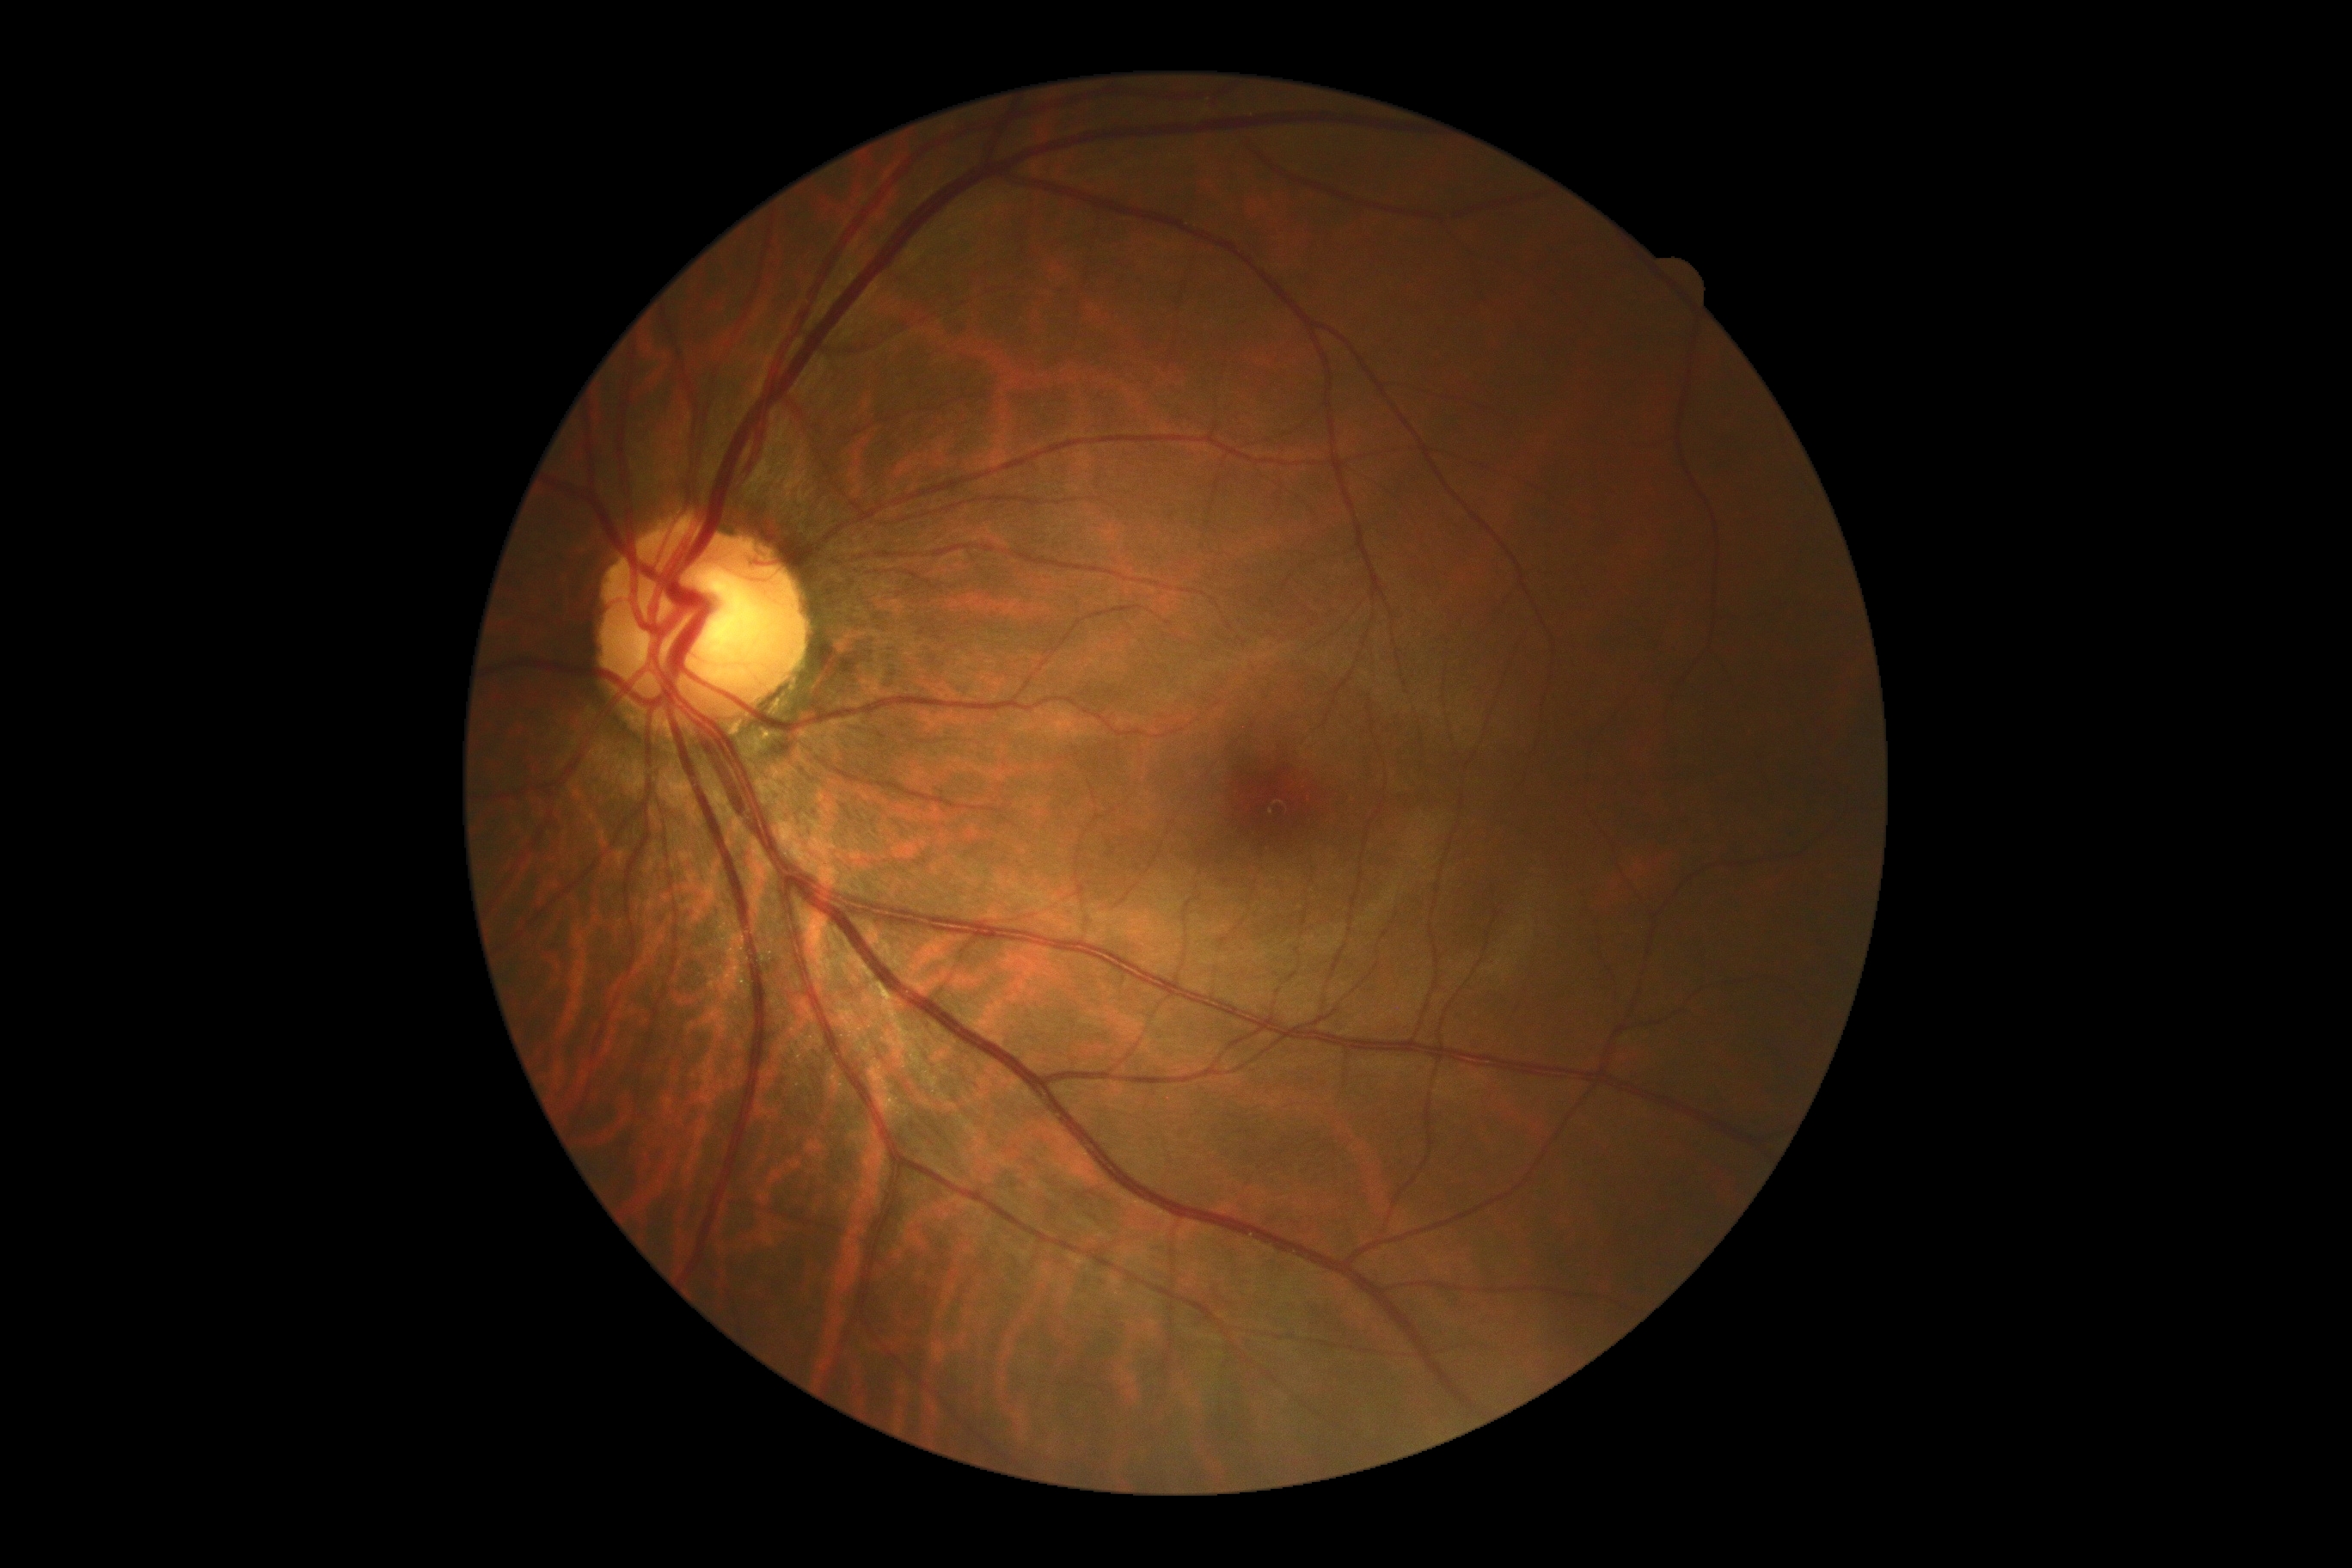

DR@grade 0 (no apparent retinopathy) — no visible signs of diabetic retinopathy.